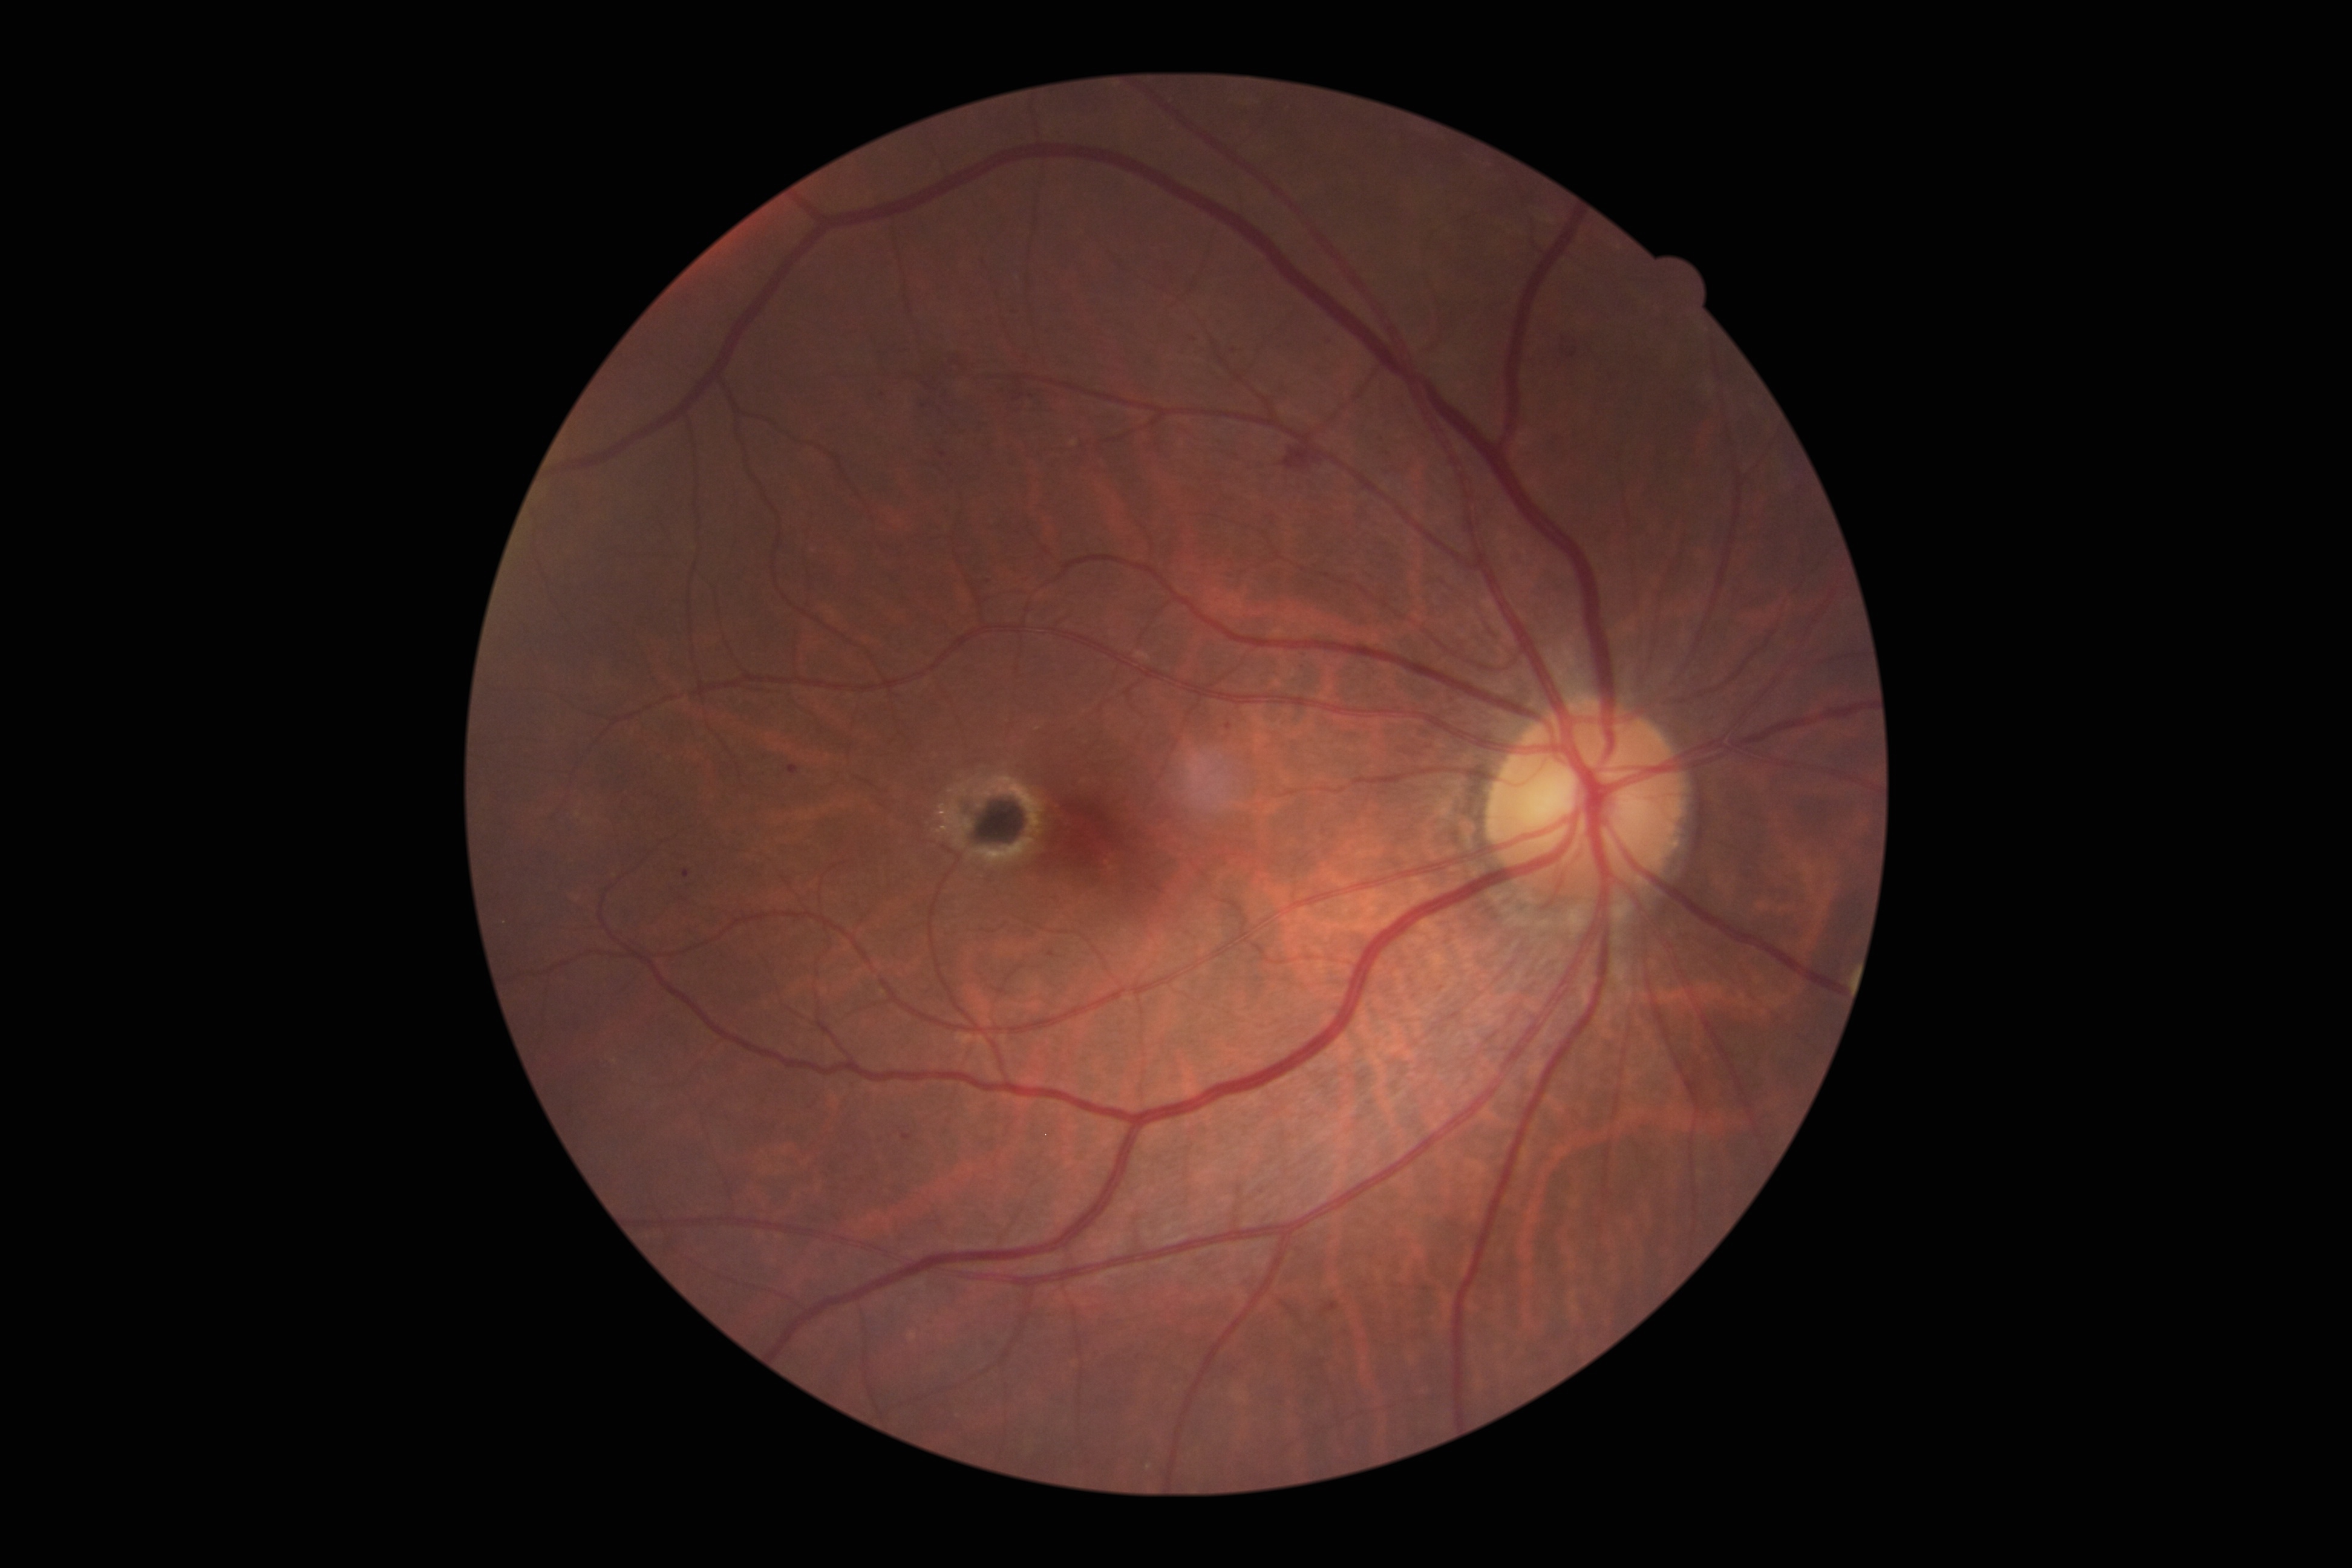 DR: grade 2.